CFP · nonmydriatic · NIDEK AFC-230 fundus camera · modified Davis classification · 45° FOV — 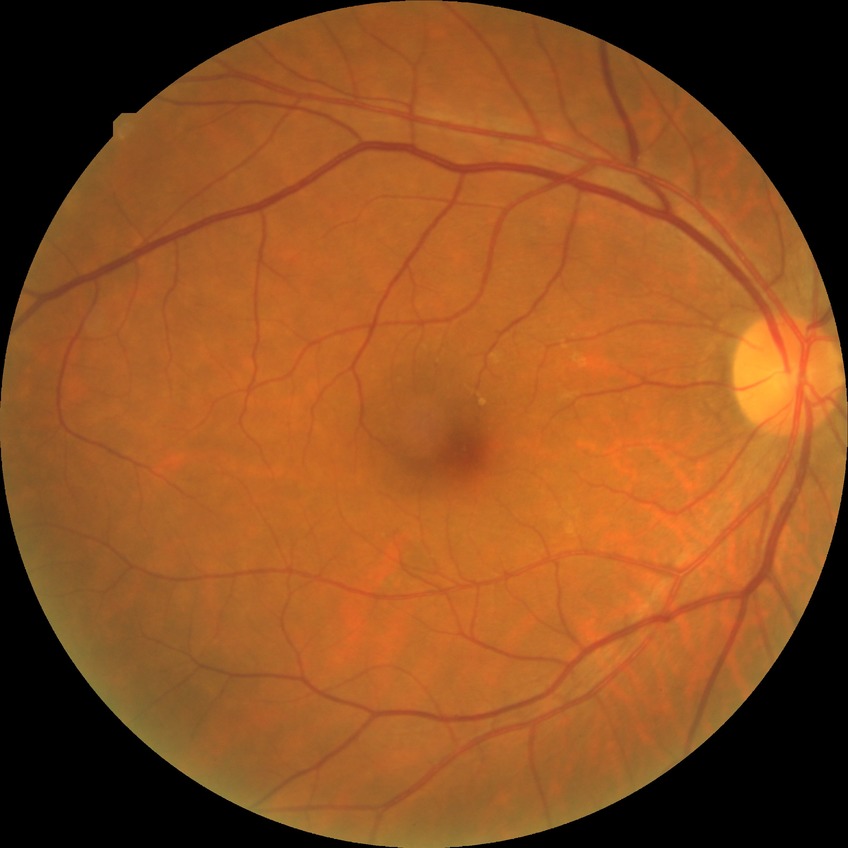
diabetic retinopathy grade: no diabetic retinopathy